45° field of view. Color fundus photograph.
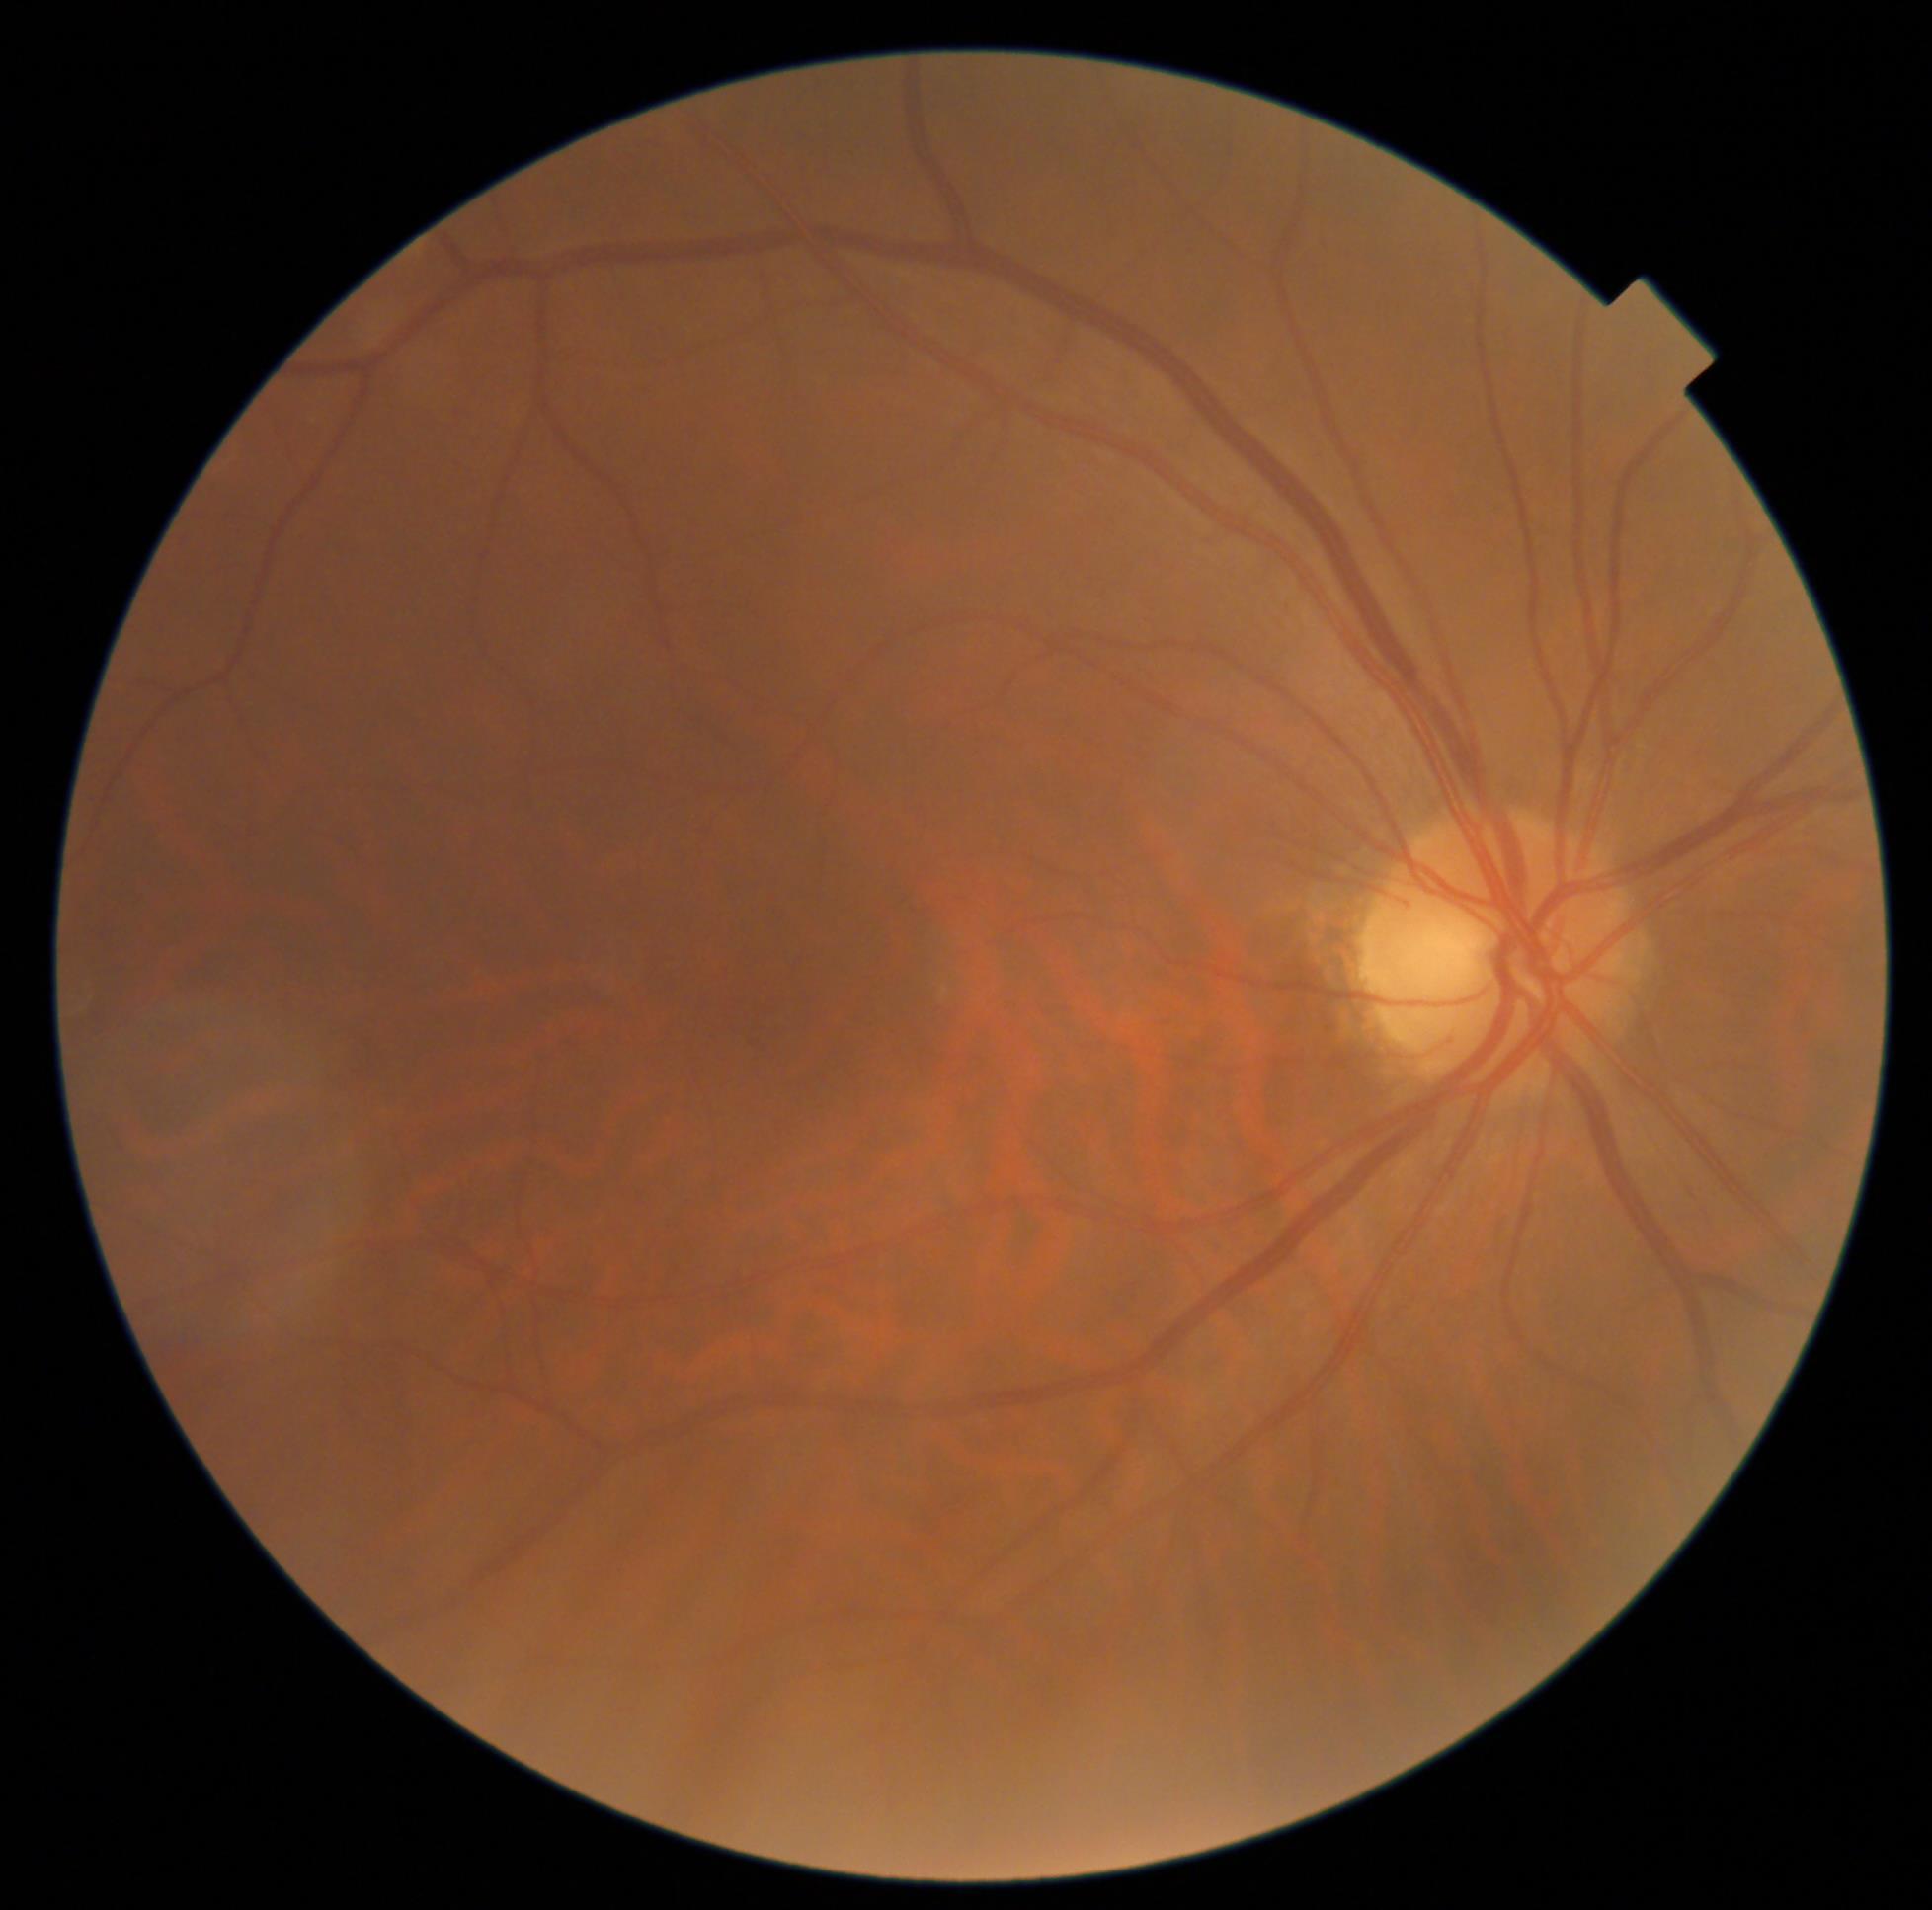

DR impression: negative for DR
DR stage: 0/4